Fundus photo, Remidio smartphone fundus camera, 1659 x 2212 pixels.
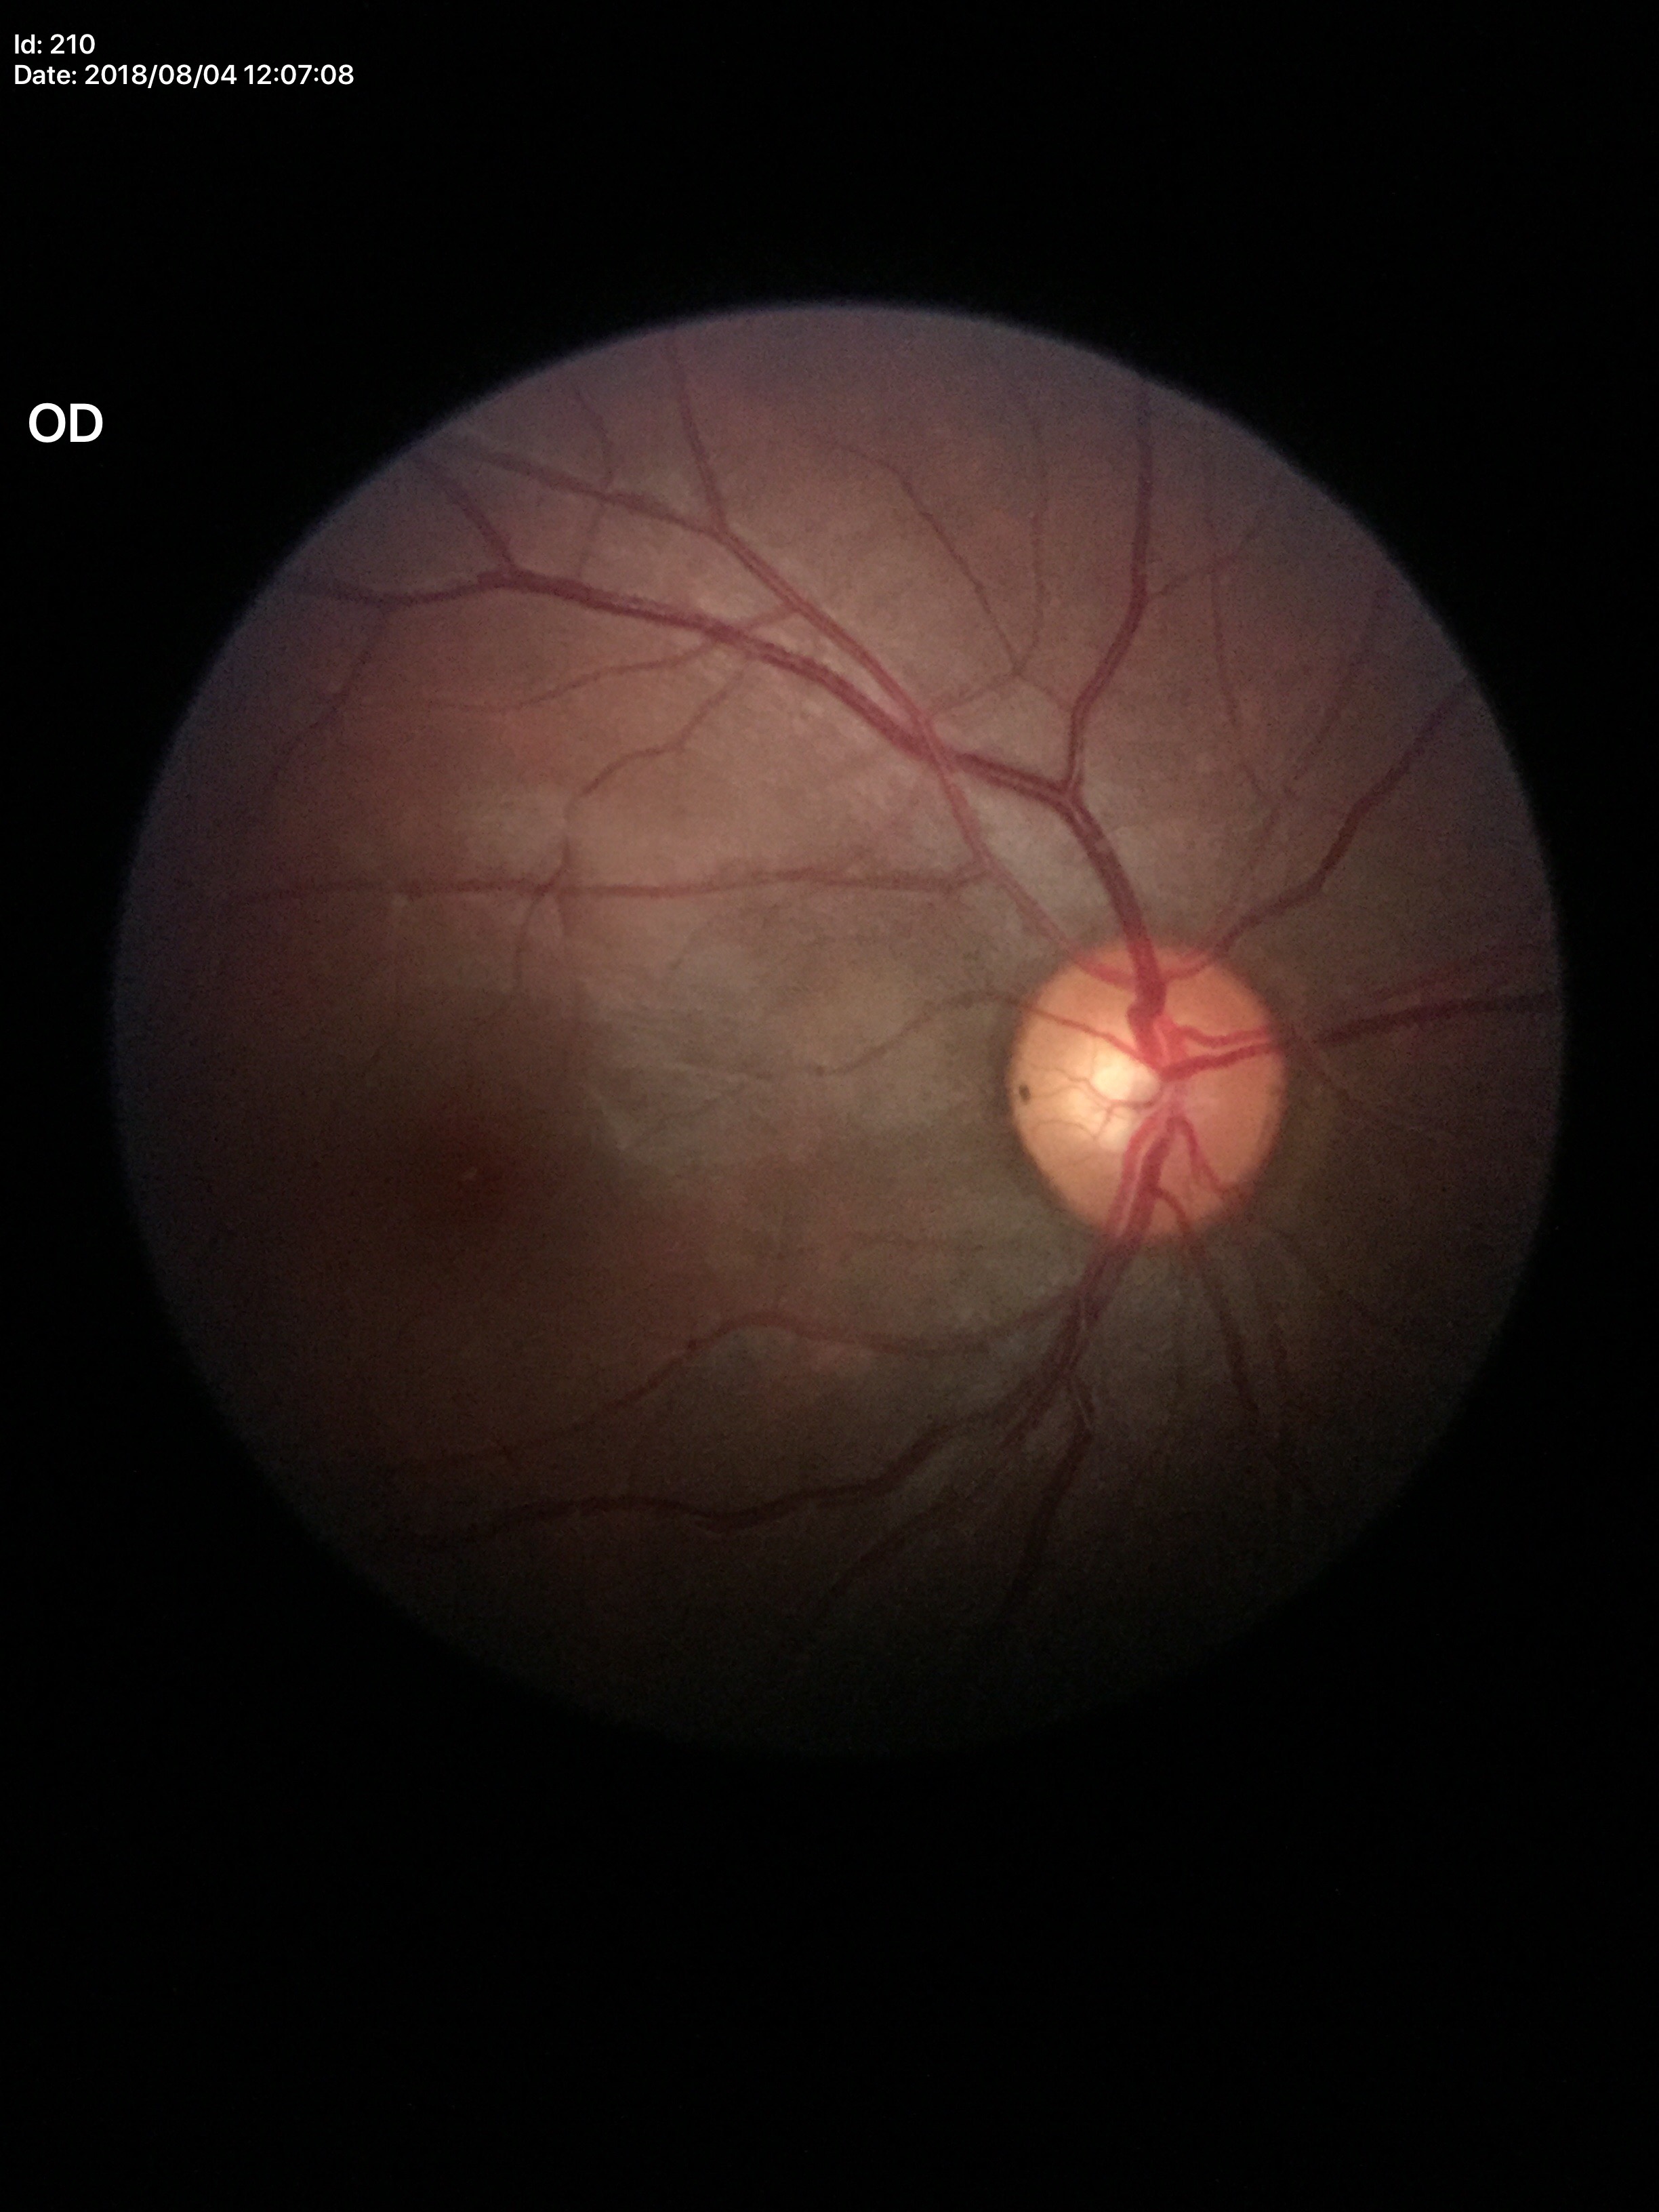 vertical C/D ratio = 0.52 | Glaucoma screening = negative (5/5 ophthalmologists in agreement) | horizontal cup-to-disc ratio = 0.51.